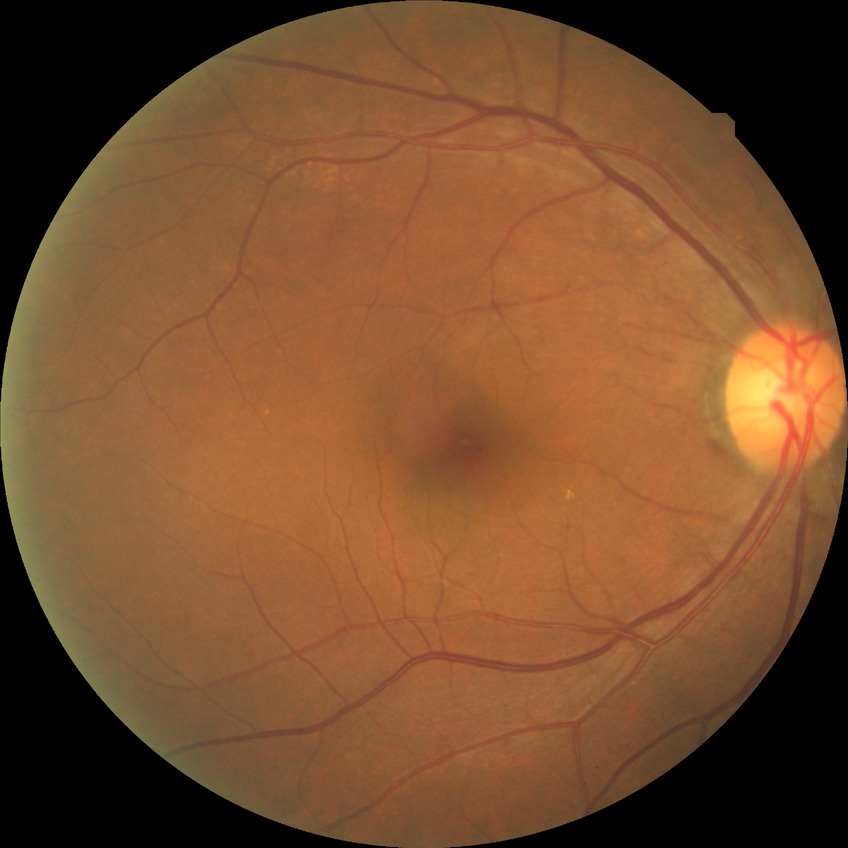
DR class: non-proliferative diabetic retinopathy; Davis grading: simple diabetic retinopathy.